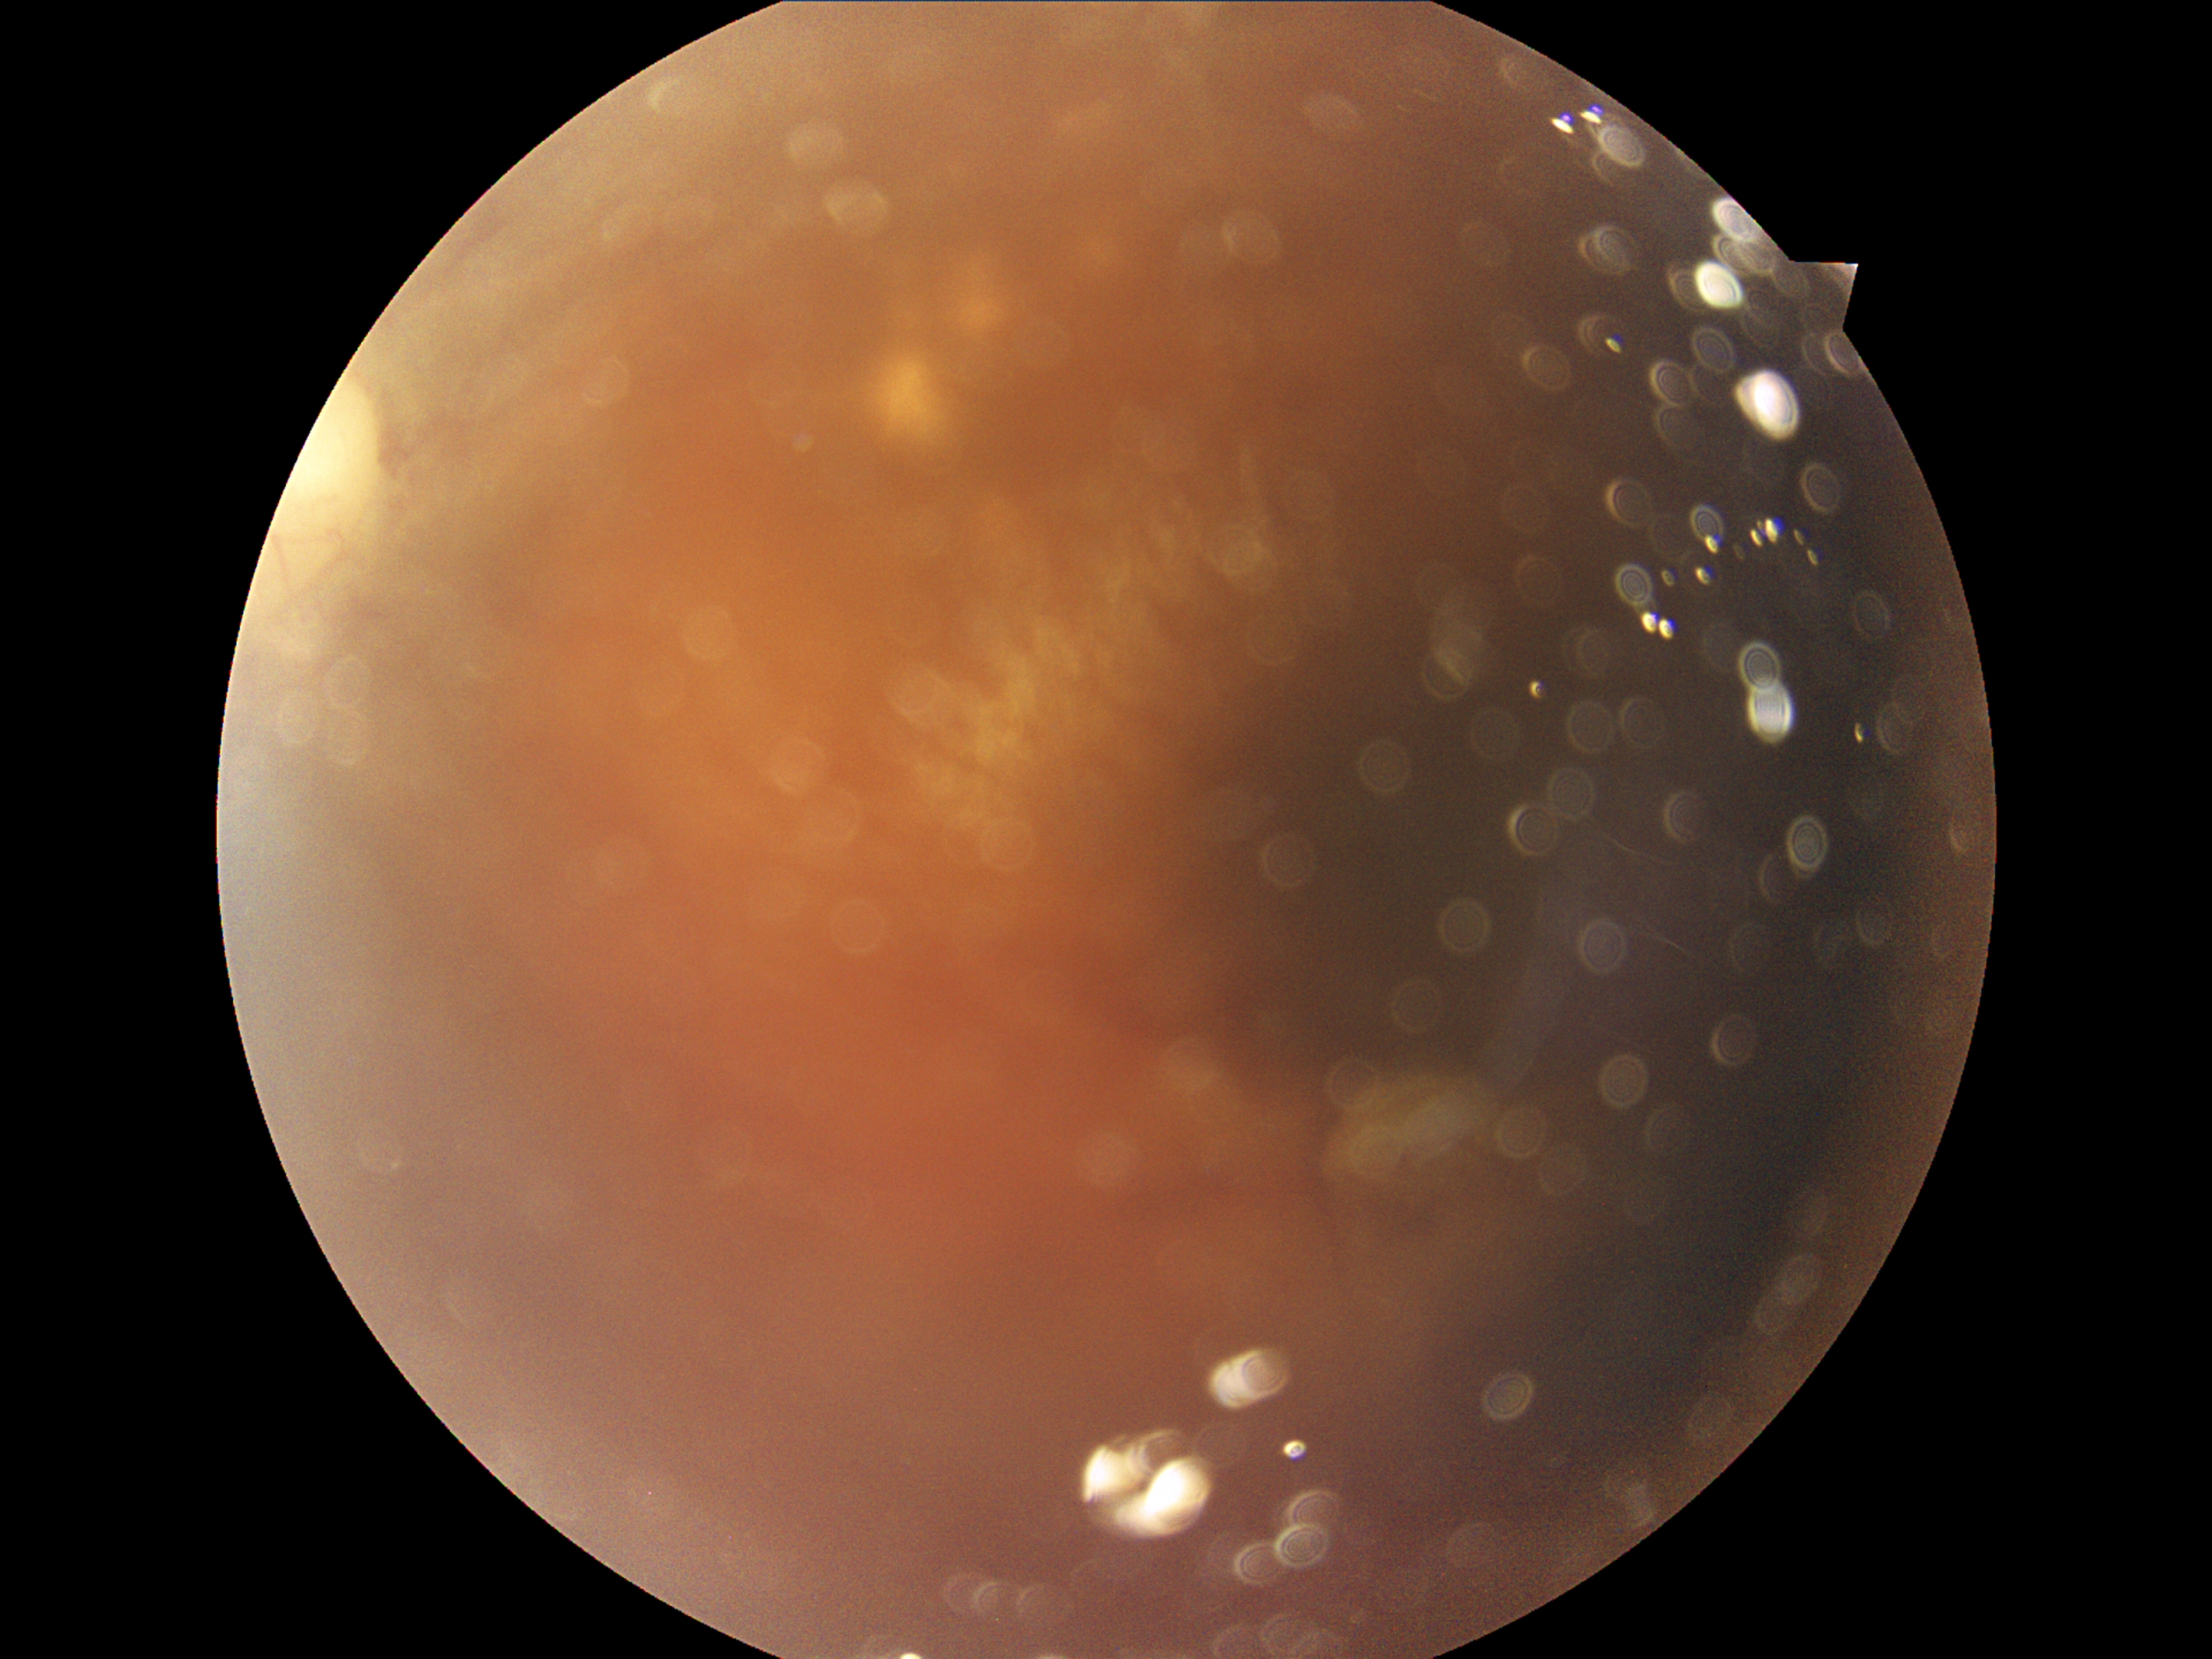

DR grade: ungradable.